45° field of view — 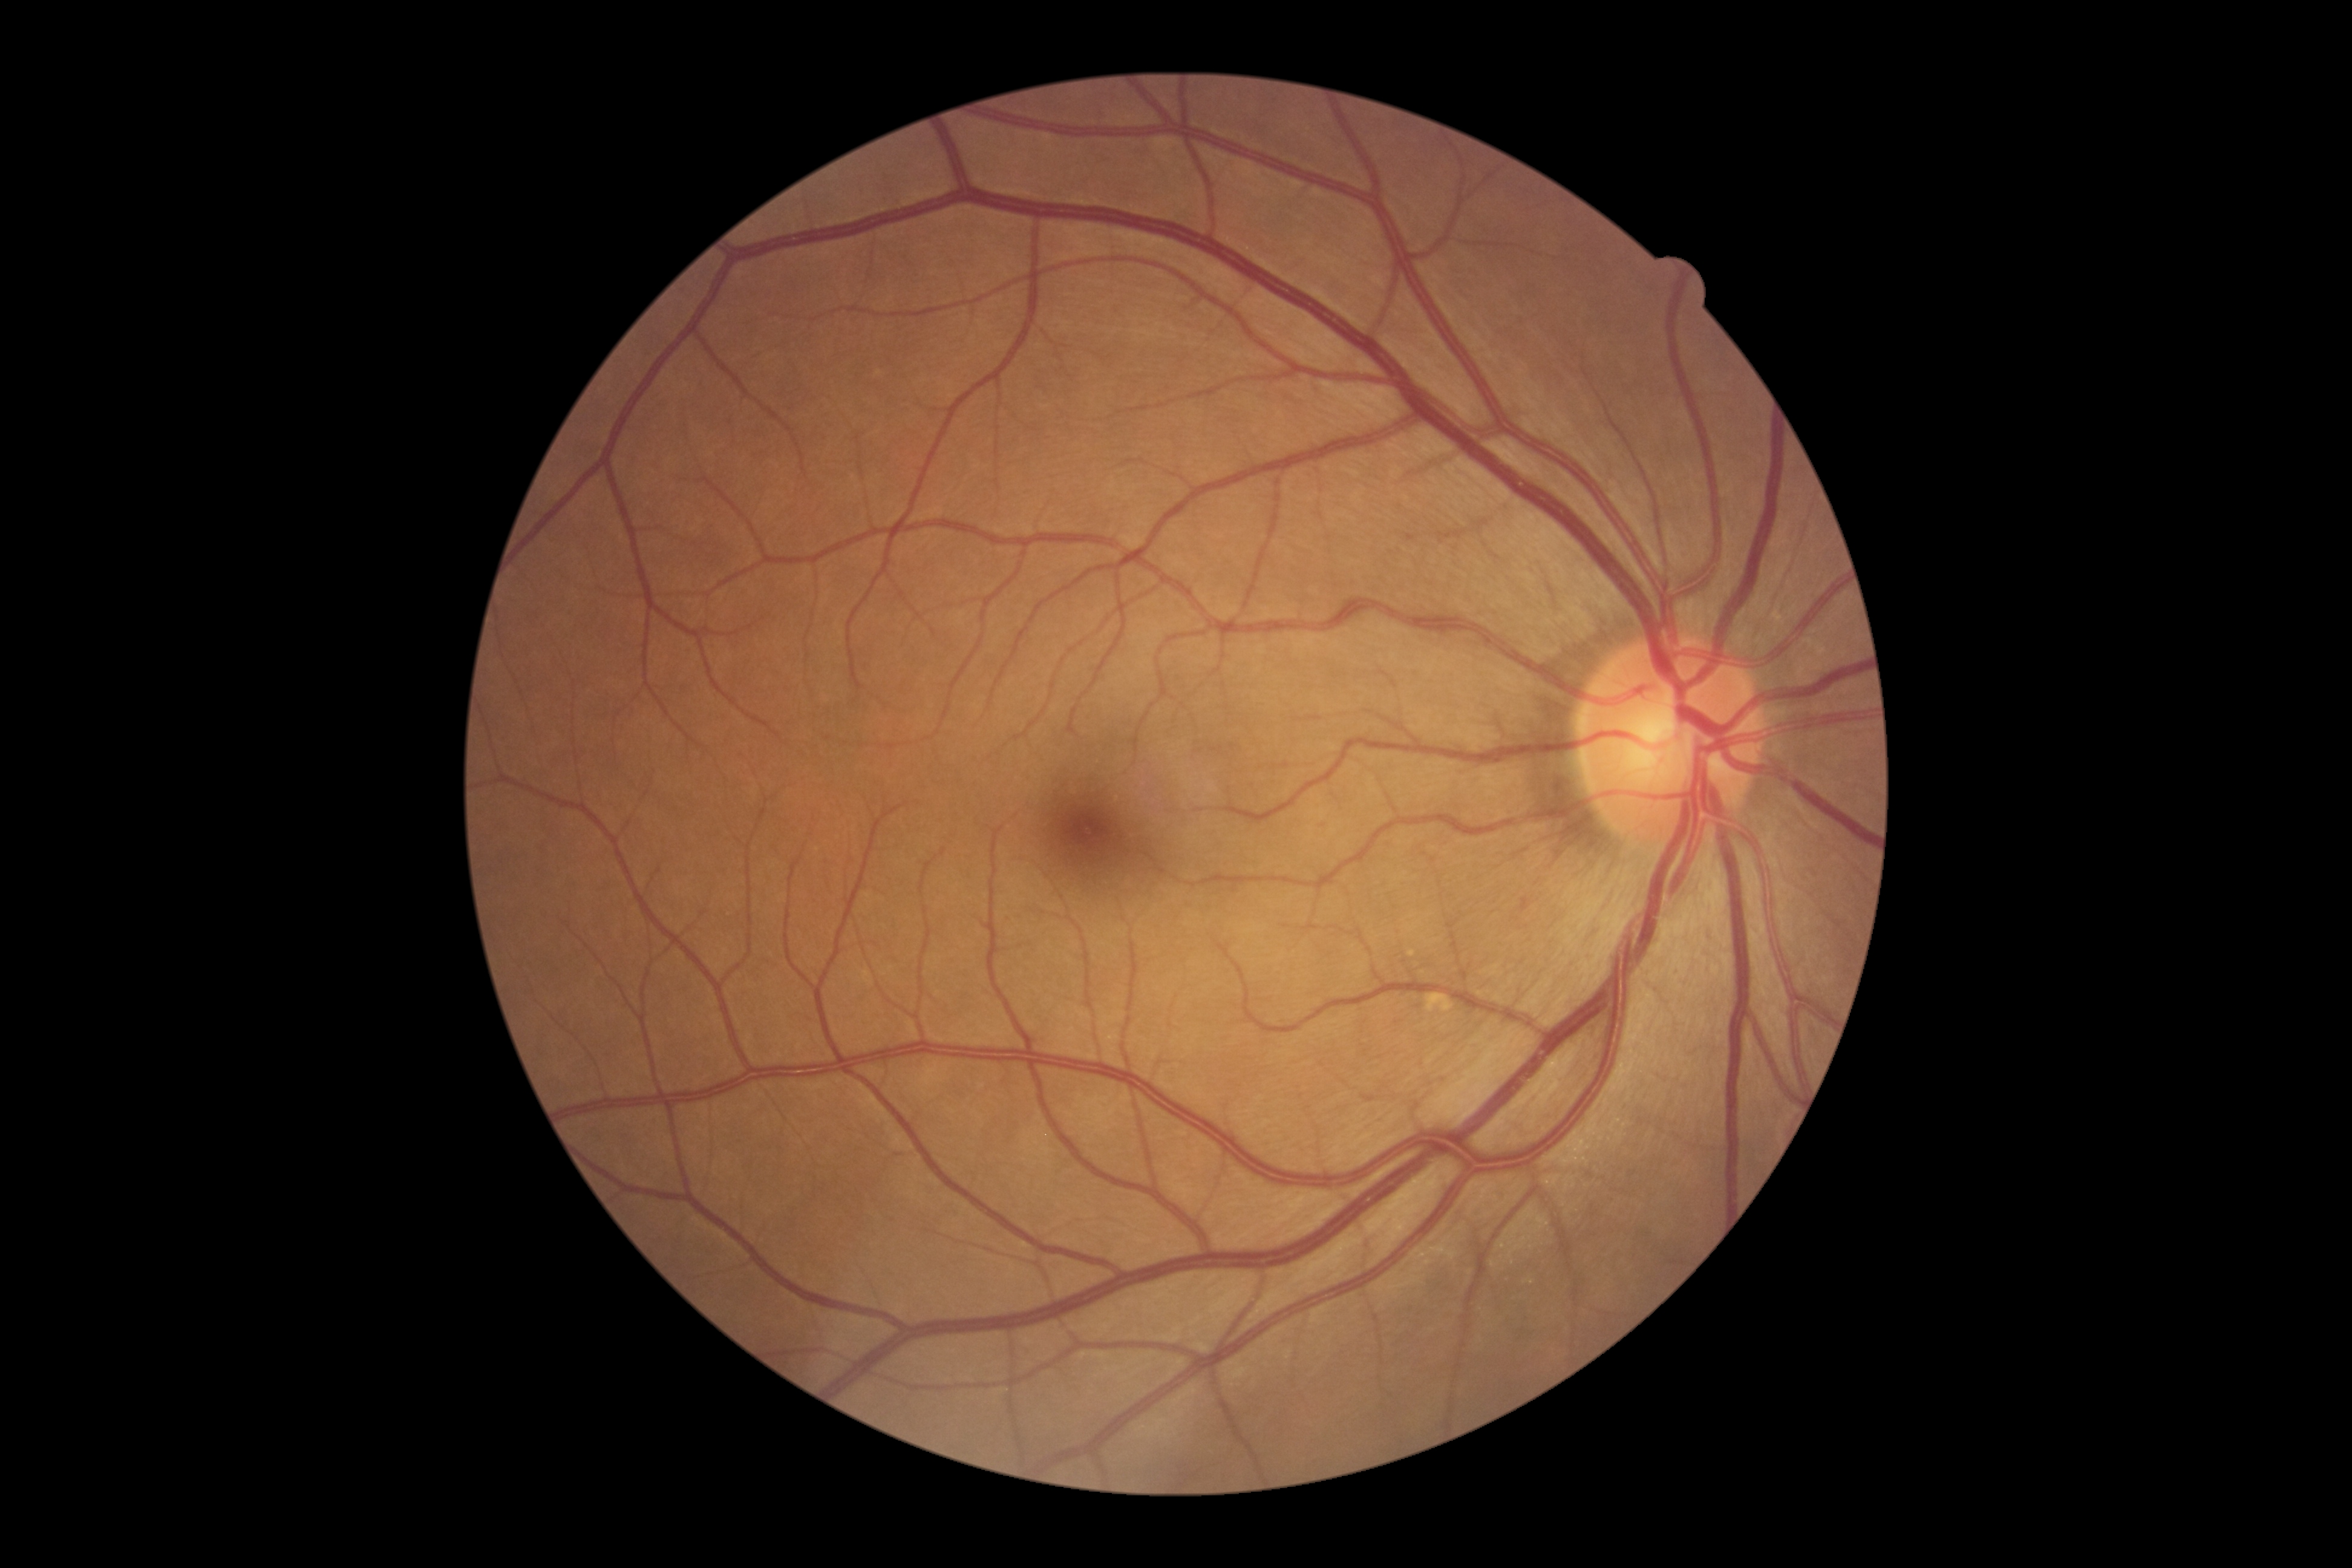 DR stage is no apparent diabetic retinopathy (grade 0).